45-degree field of view, retinal fundus photograph
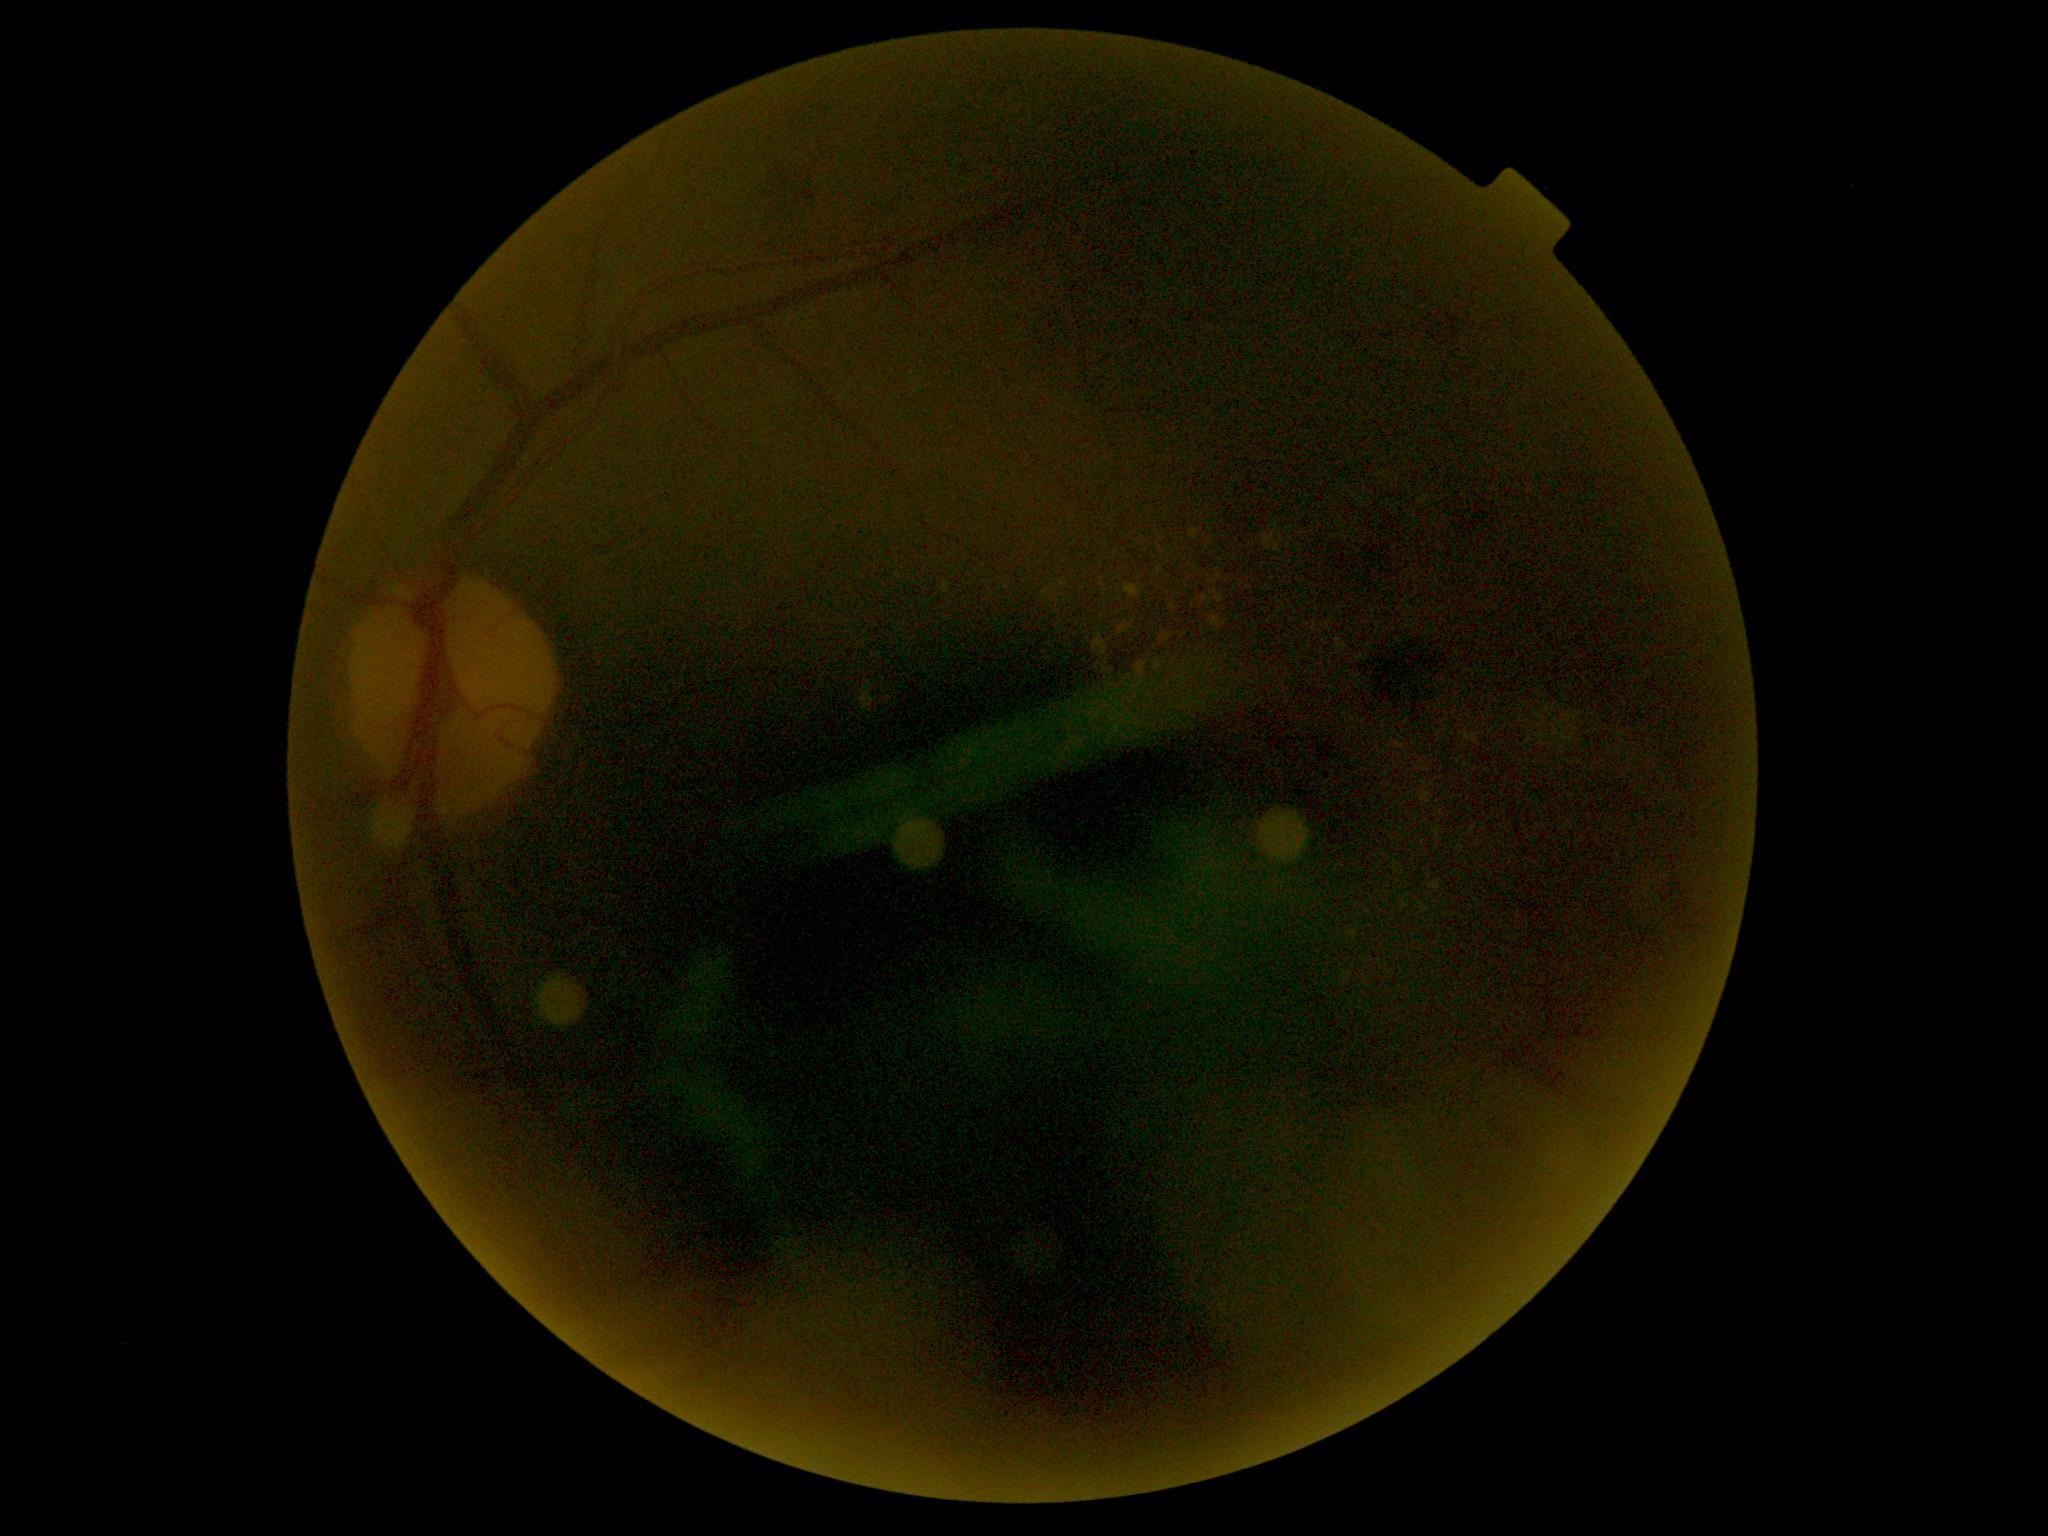

Diabetic retinopathy (DR) is 2/4 — more than just microaneurysms but less than severe NPDR.